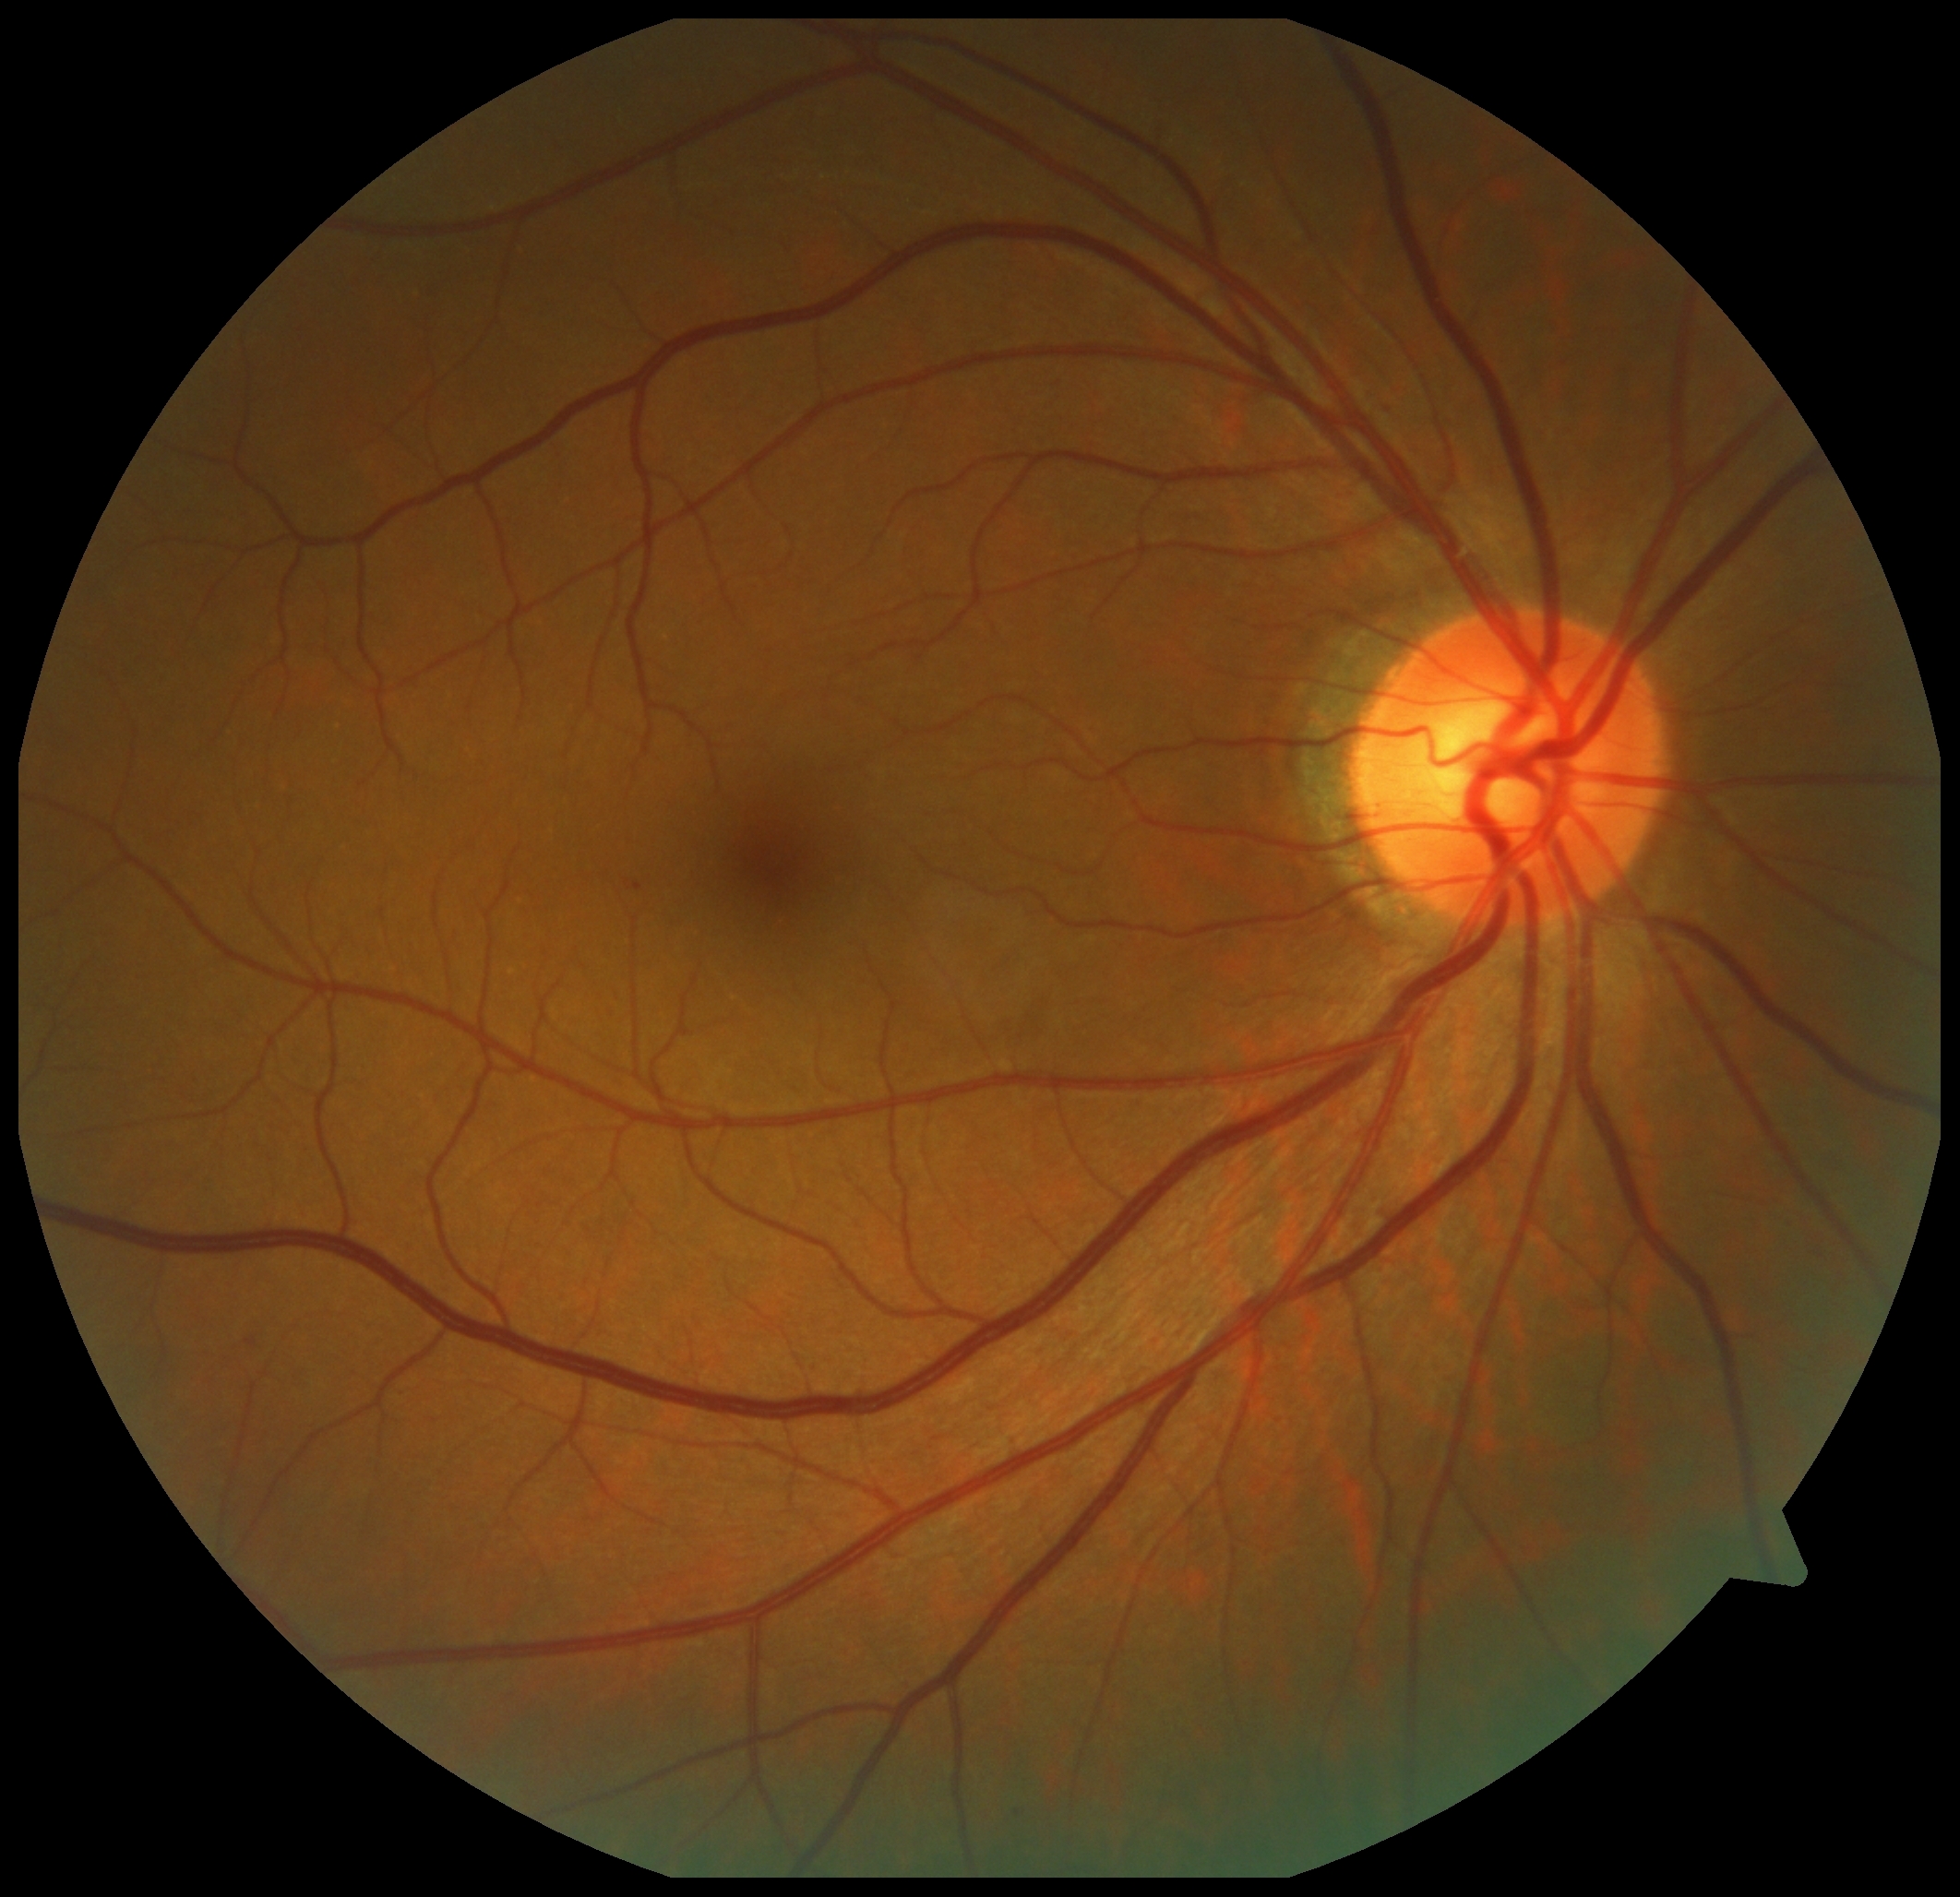

Diabetic retinopathy severity is grade 1 (mild NPDR).